Image size 2048x1536. FOV: 45 degrees. Retinal fundus photograph
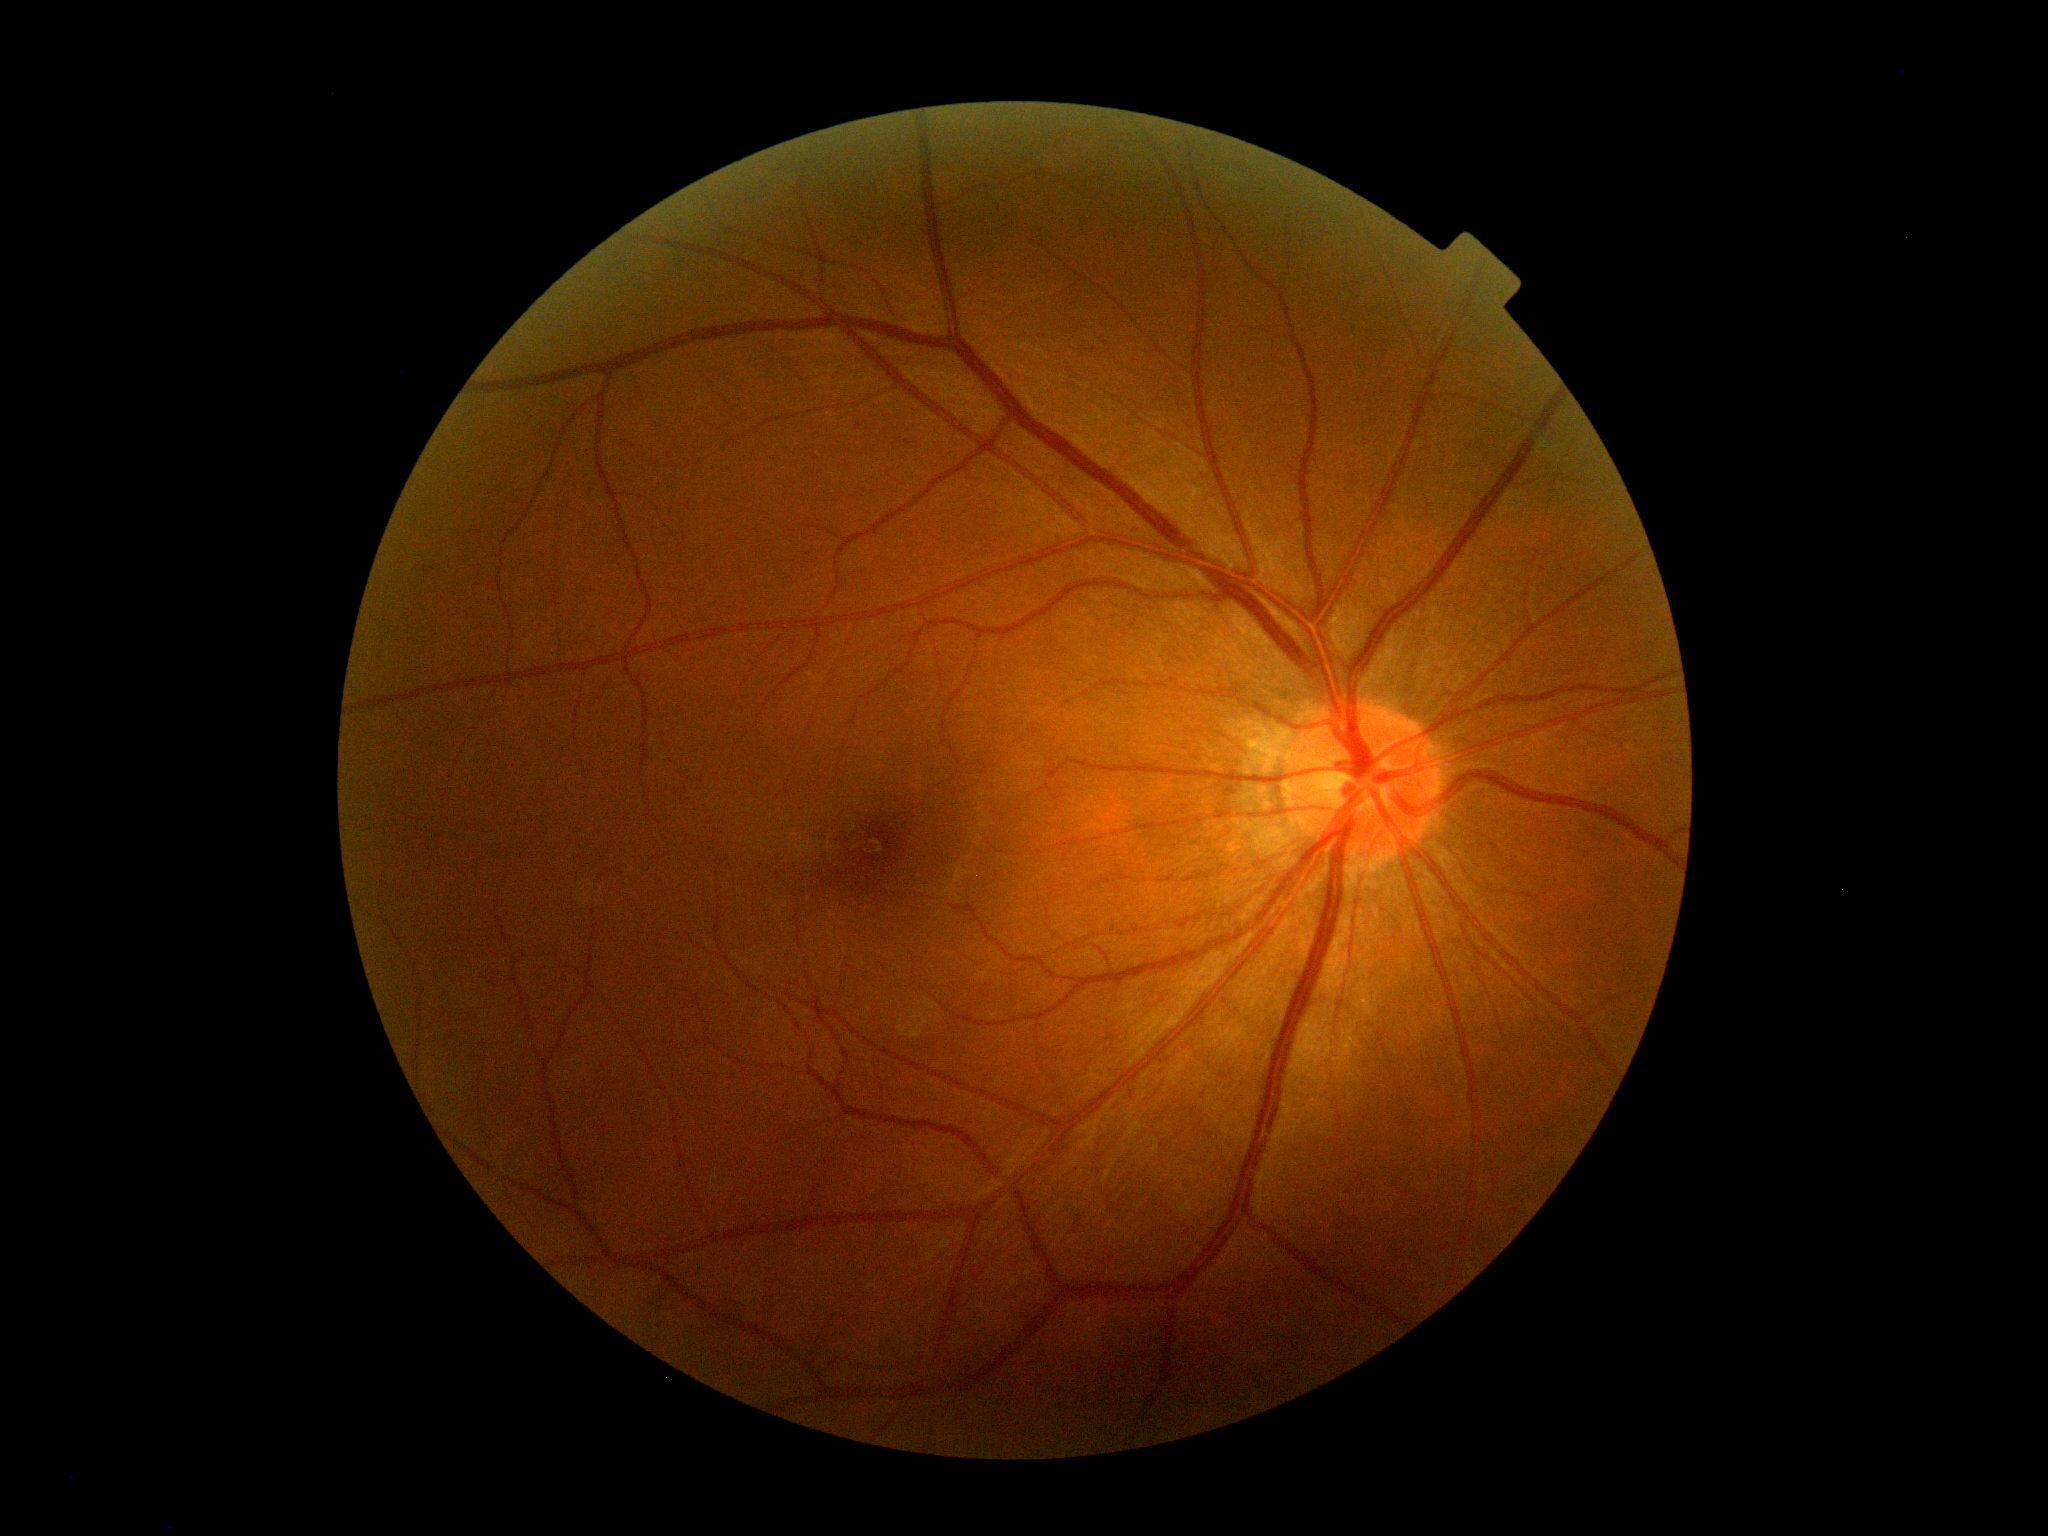

No signs of diabetic retinopathy. Retinopathy is no apparent diabetic retinopathy (grade 0).